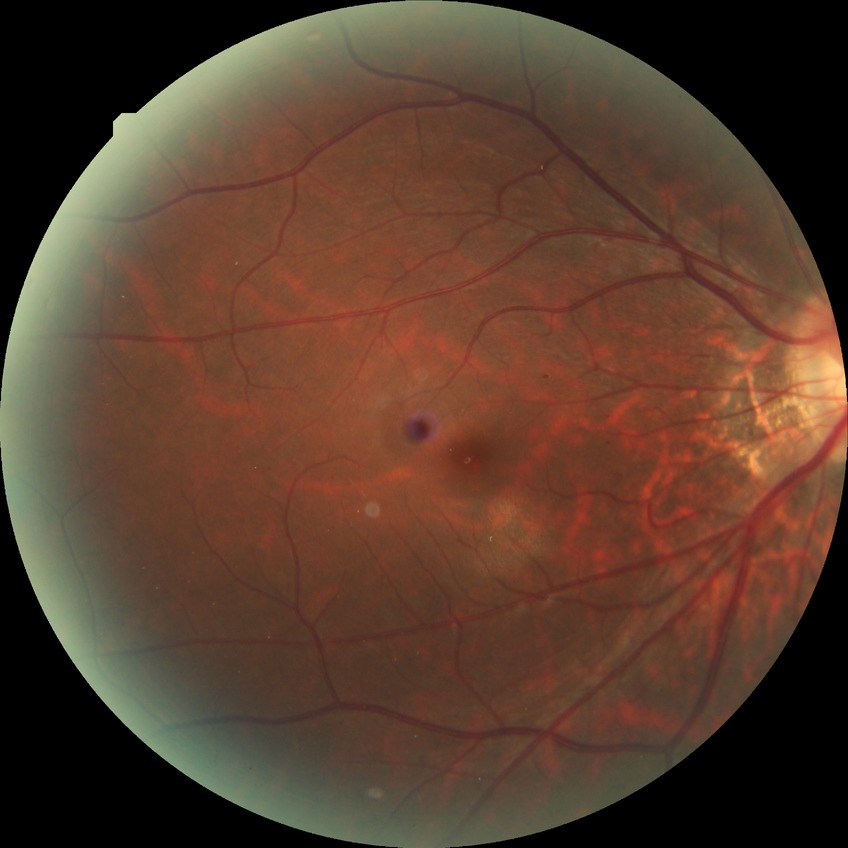

diabetic retinopathy (DR): simple diabetic retinopathy (SDR); DR class: non-proliferative diabetic retinopathy.